Captured on a Bosch handheld fundus camera, color fundus photograph, 1920x1440: 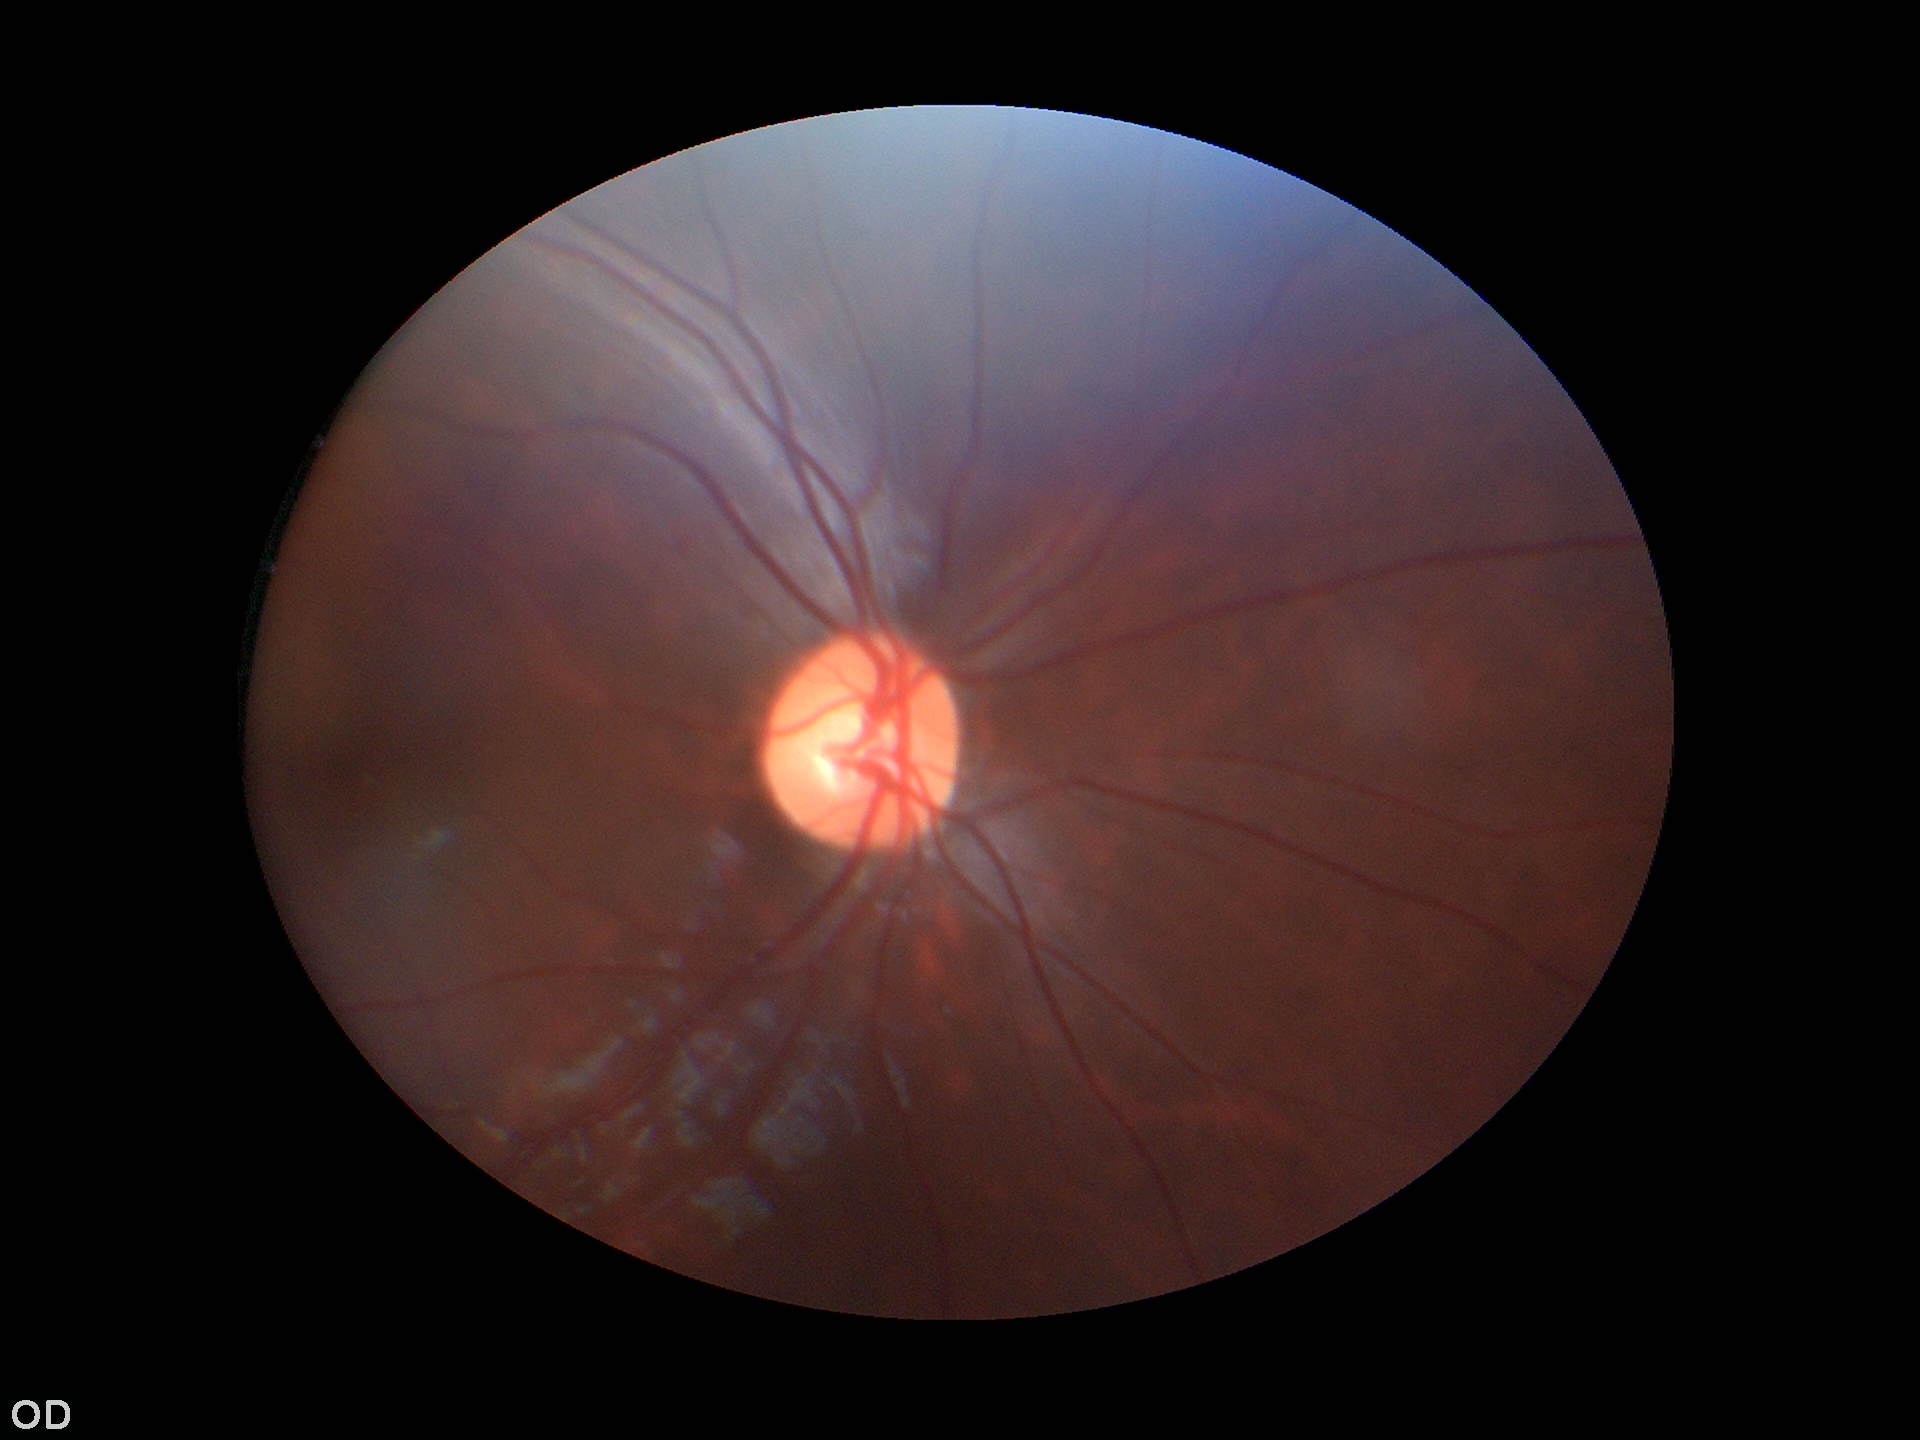 ACDR is 0.28. VCDR: 0.52. No glaucomatous findings. HCDR of 0.56.